FOV: 200 degrees, wide-field retinal mosaic image:
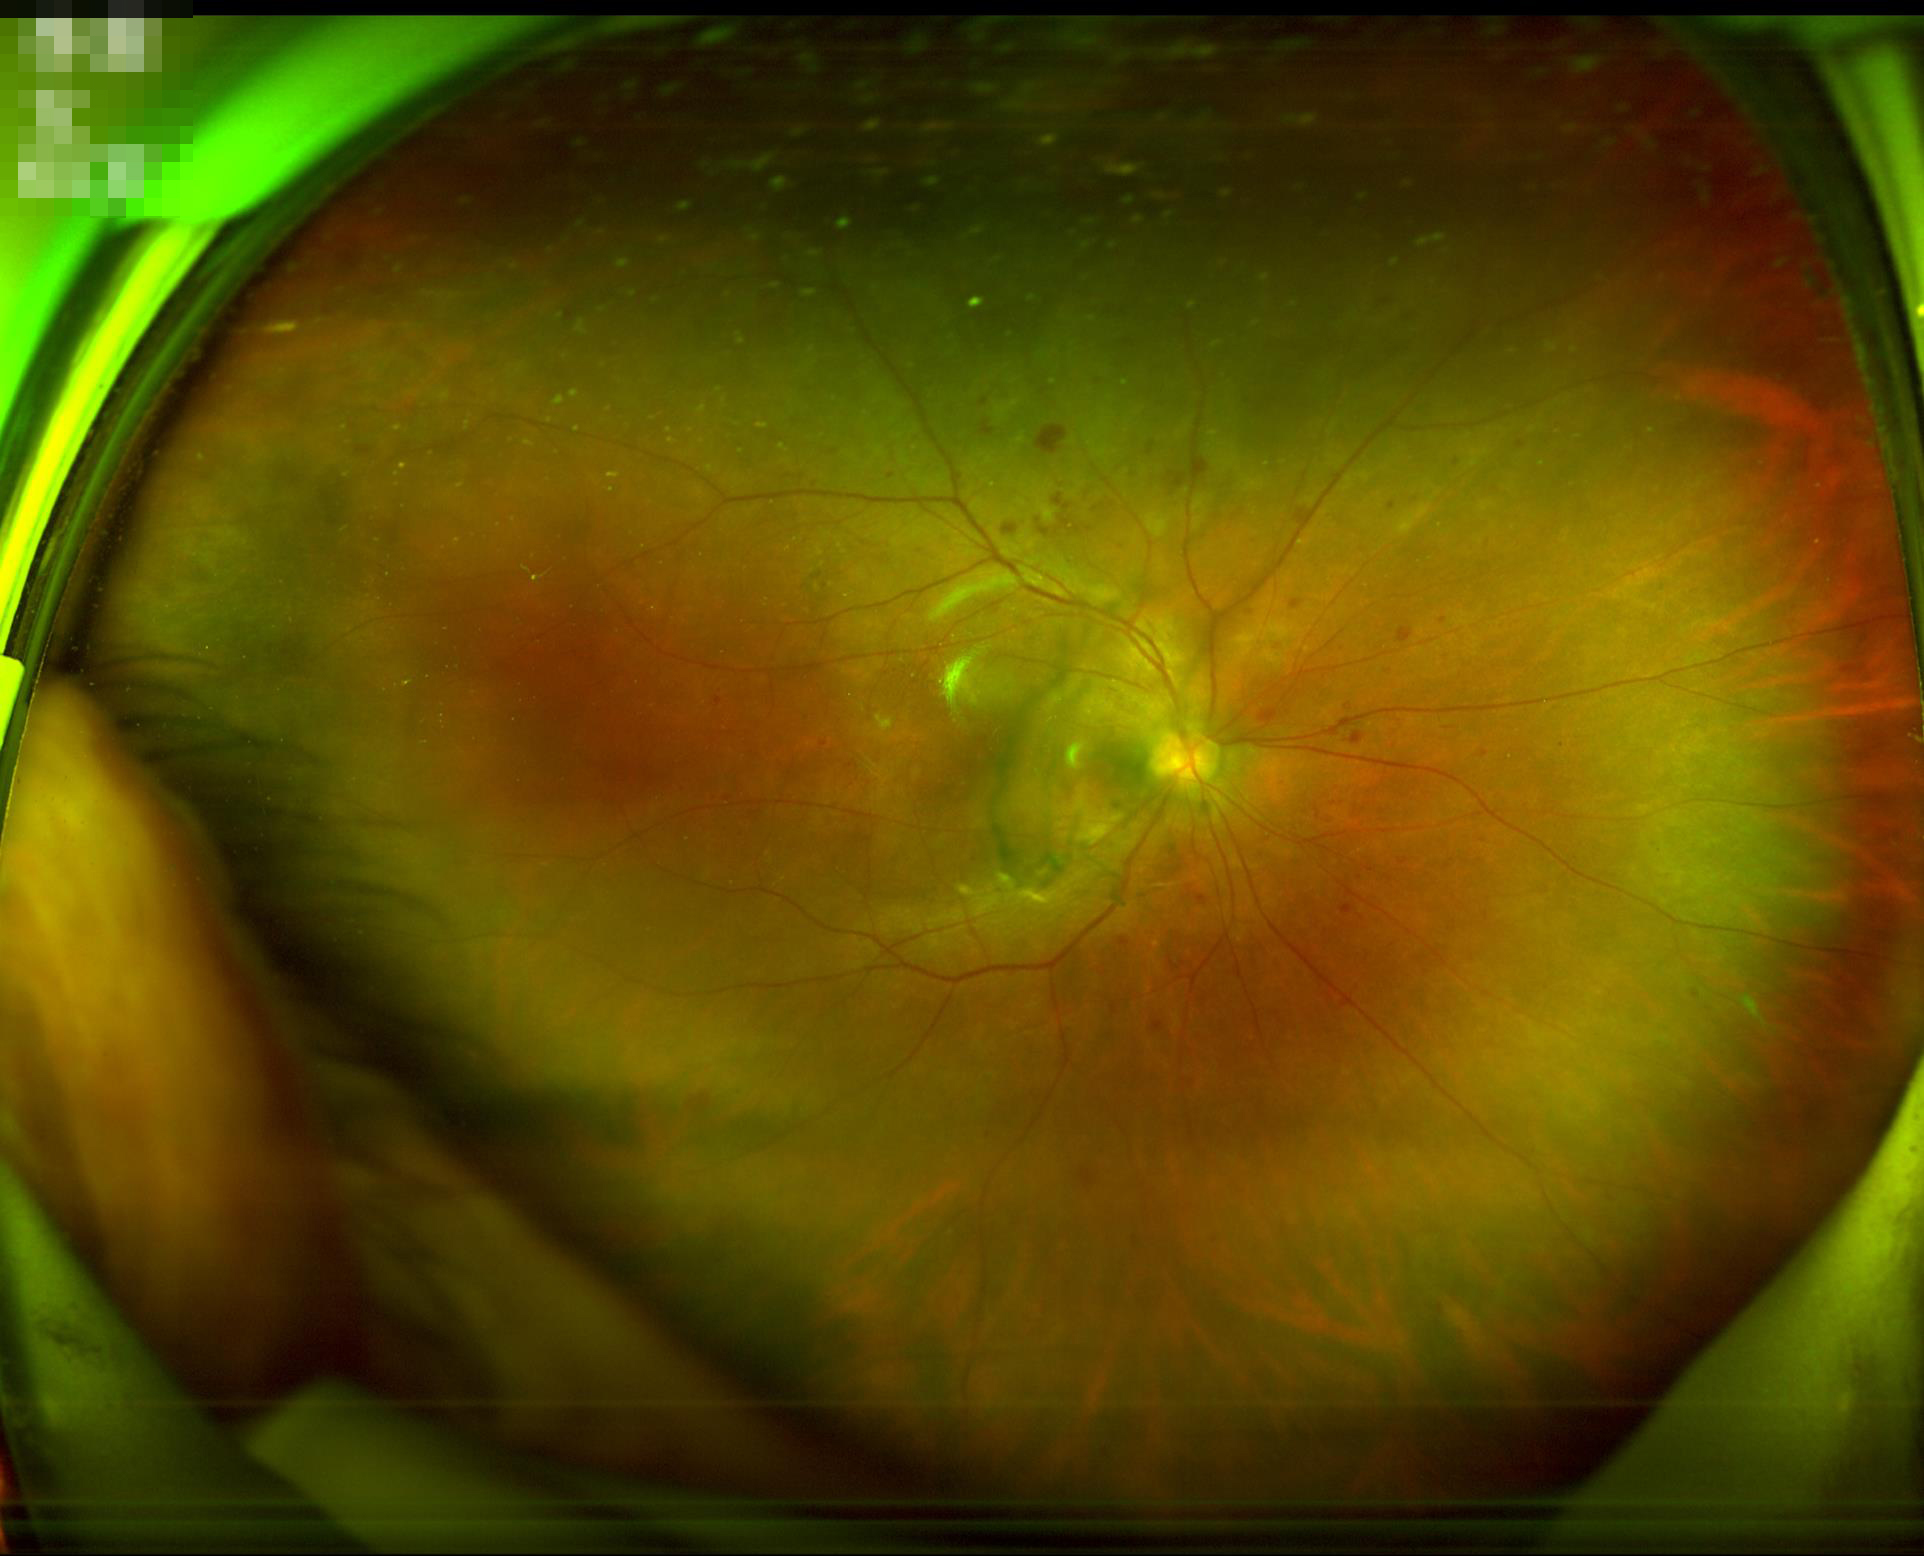

Even illumination with no color cast. Overall image quality is good. Image is sharp throughout the field.